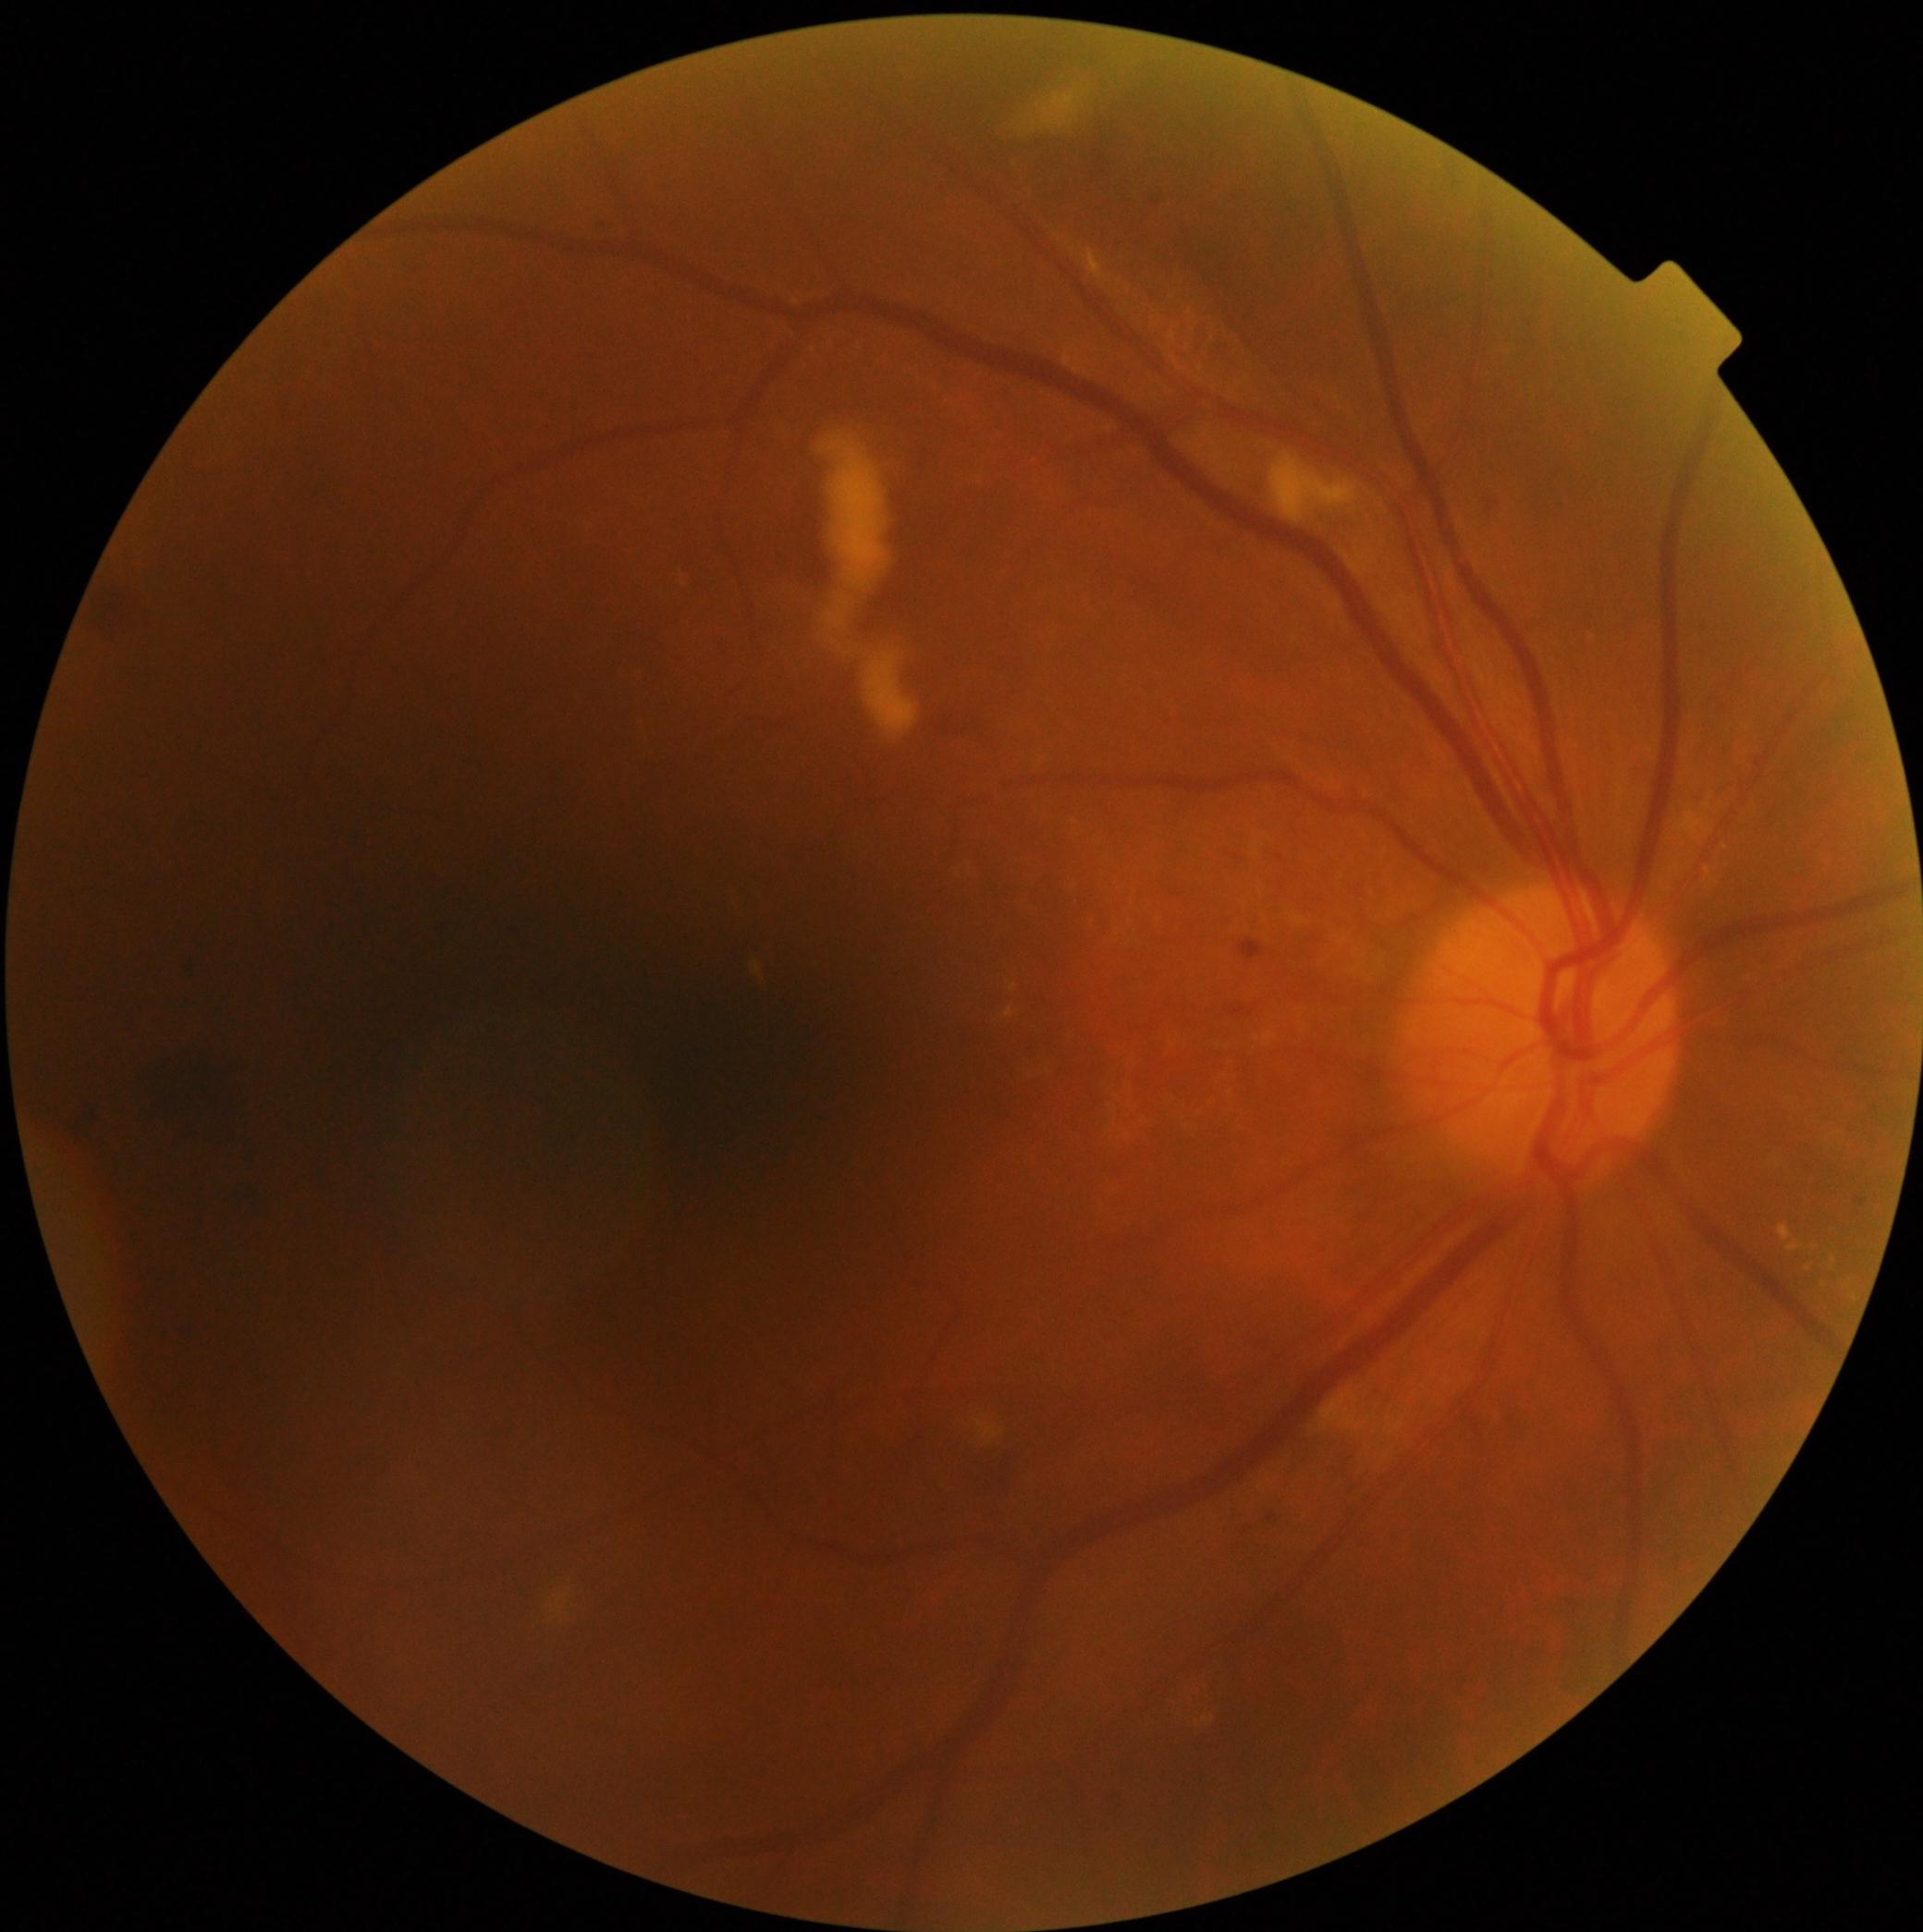 DR stage = grade 2 (moderate NPDR).